Pediatric wide-field fundus photograph · acquired on the Clarity RetCam 3.
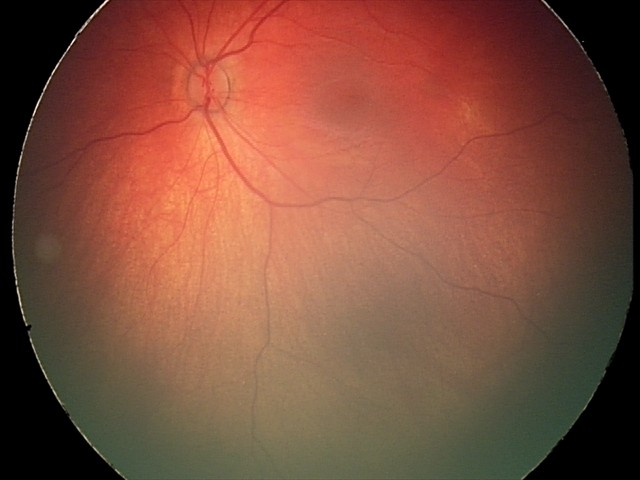 Screening diagnosis: retinal hemorrhages.